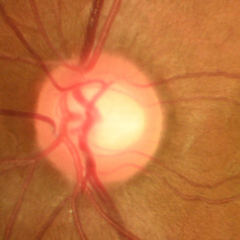
No evidence of glaucoma.